45° field of view · 1960x1897px — 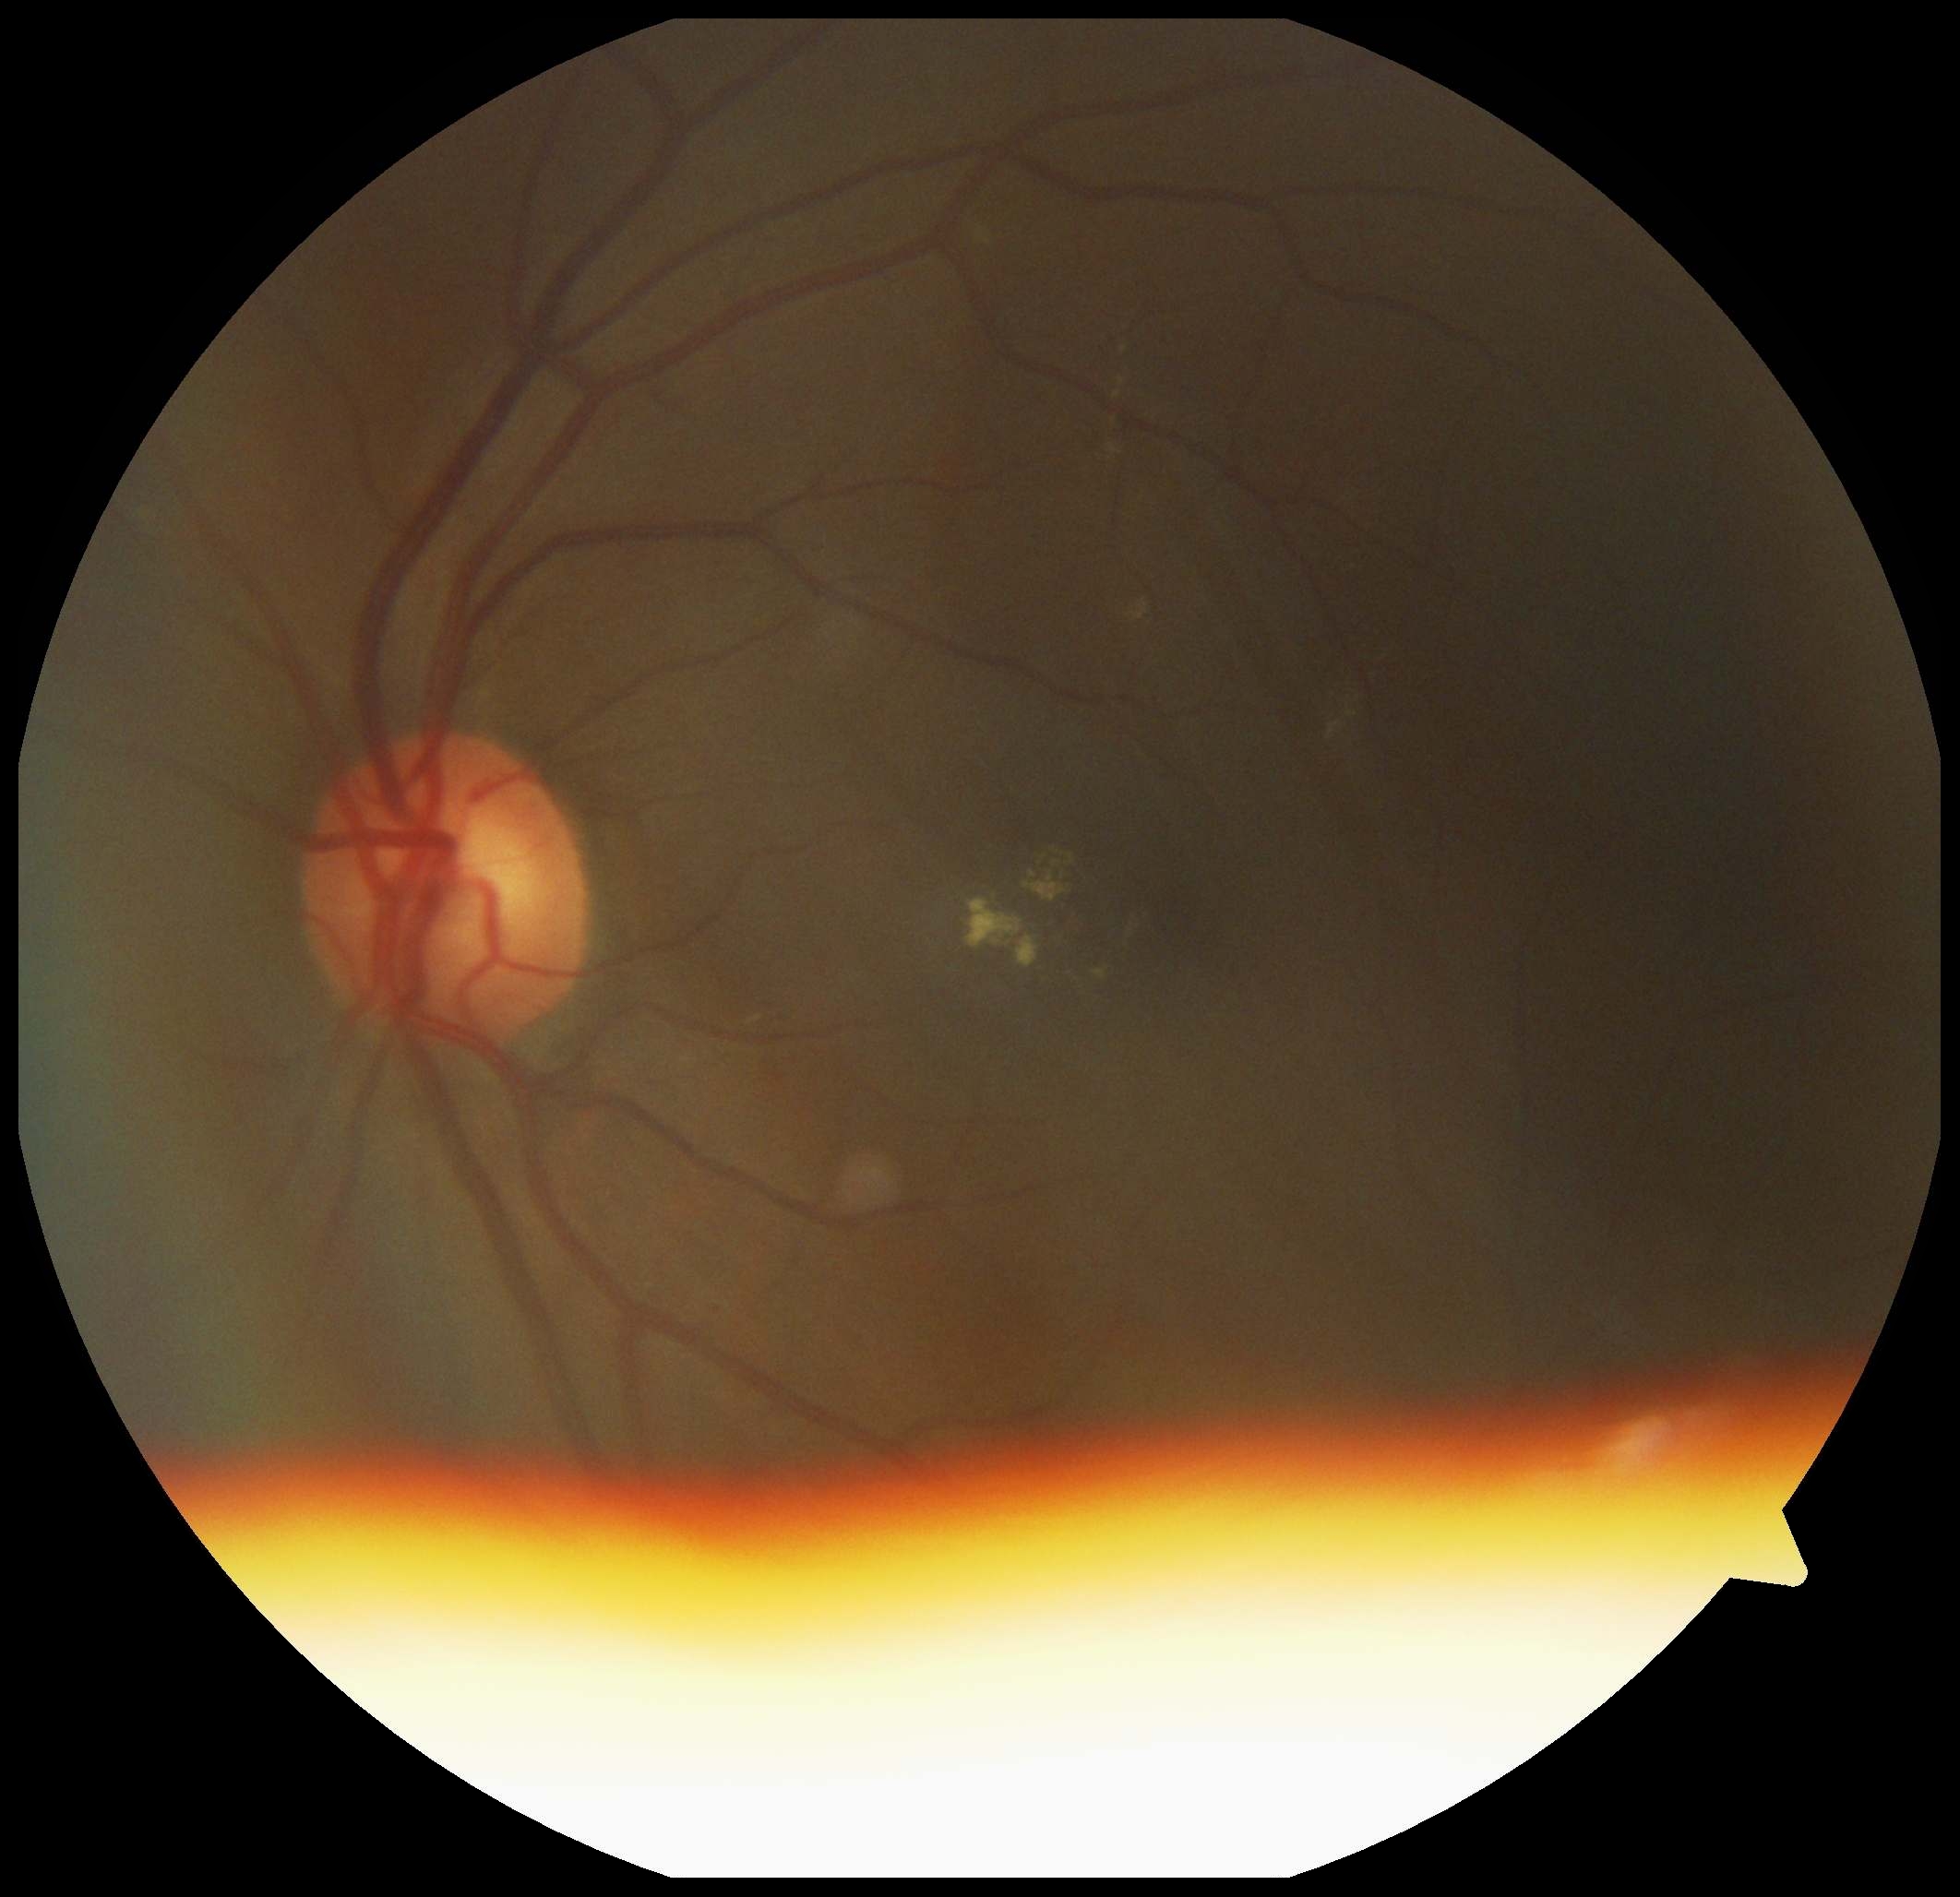
Findings:
– diabetic retinopathy grade — moderate non-proliferative diabetic retinopathy (2)